Color fundus image; 1932 x 1916 pixels
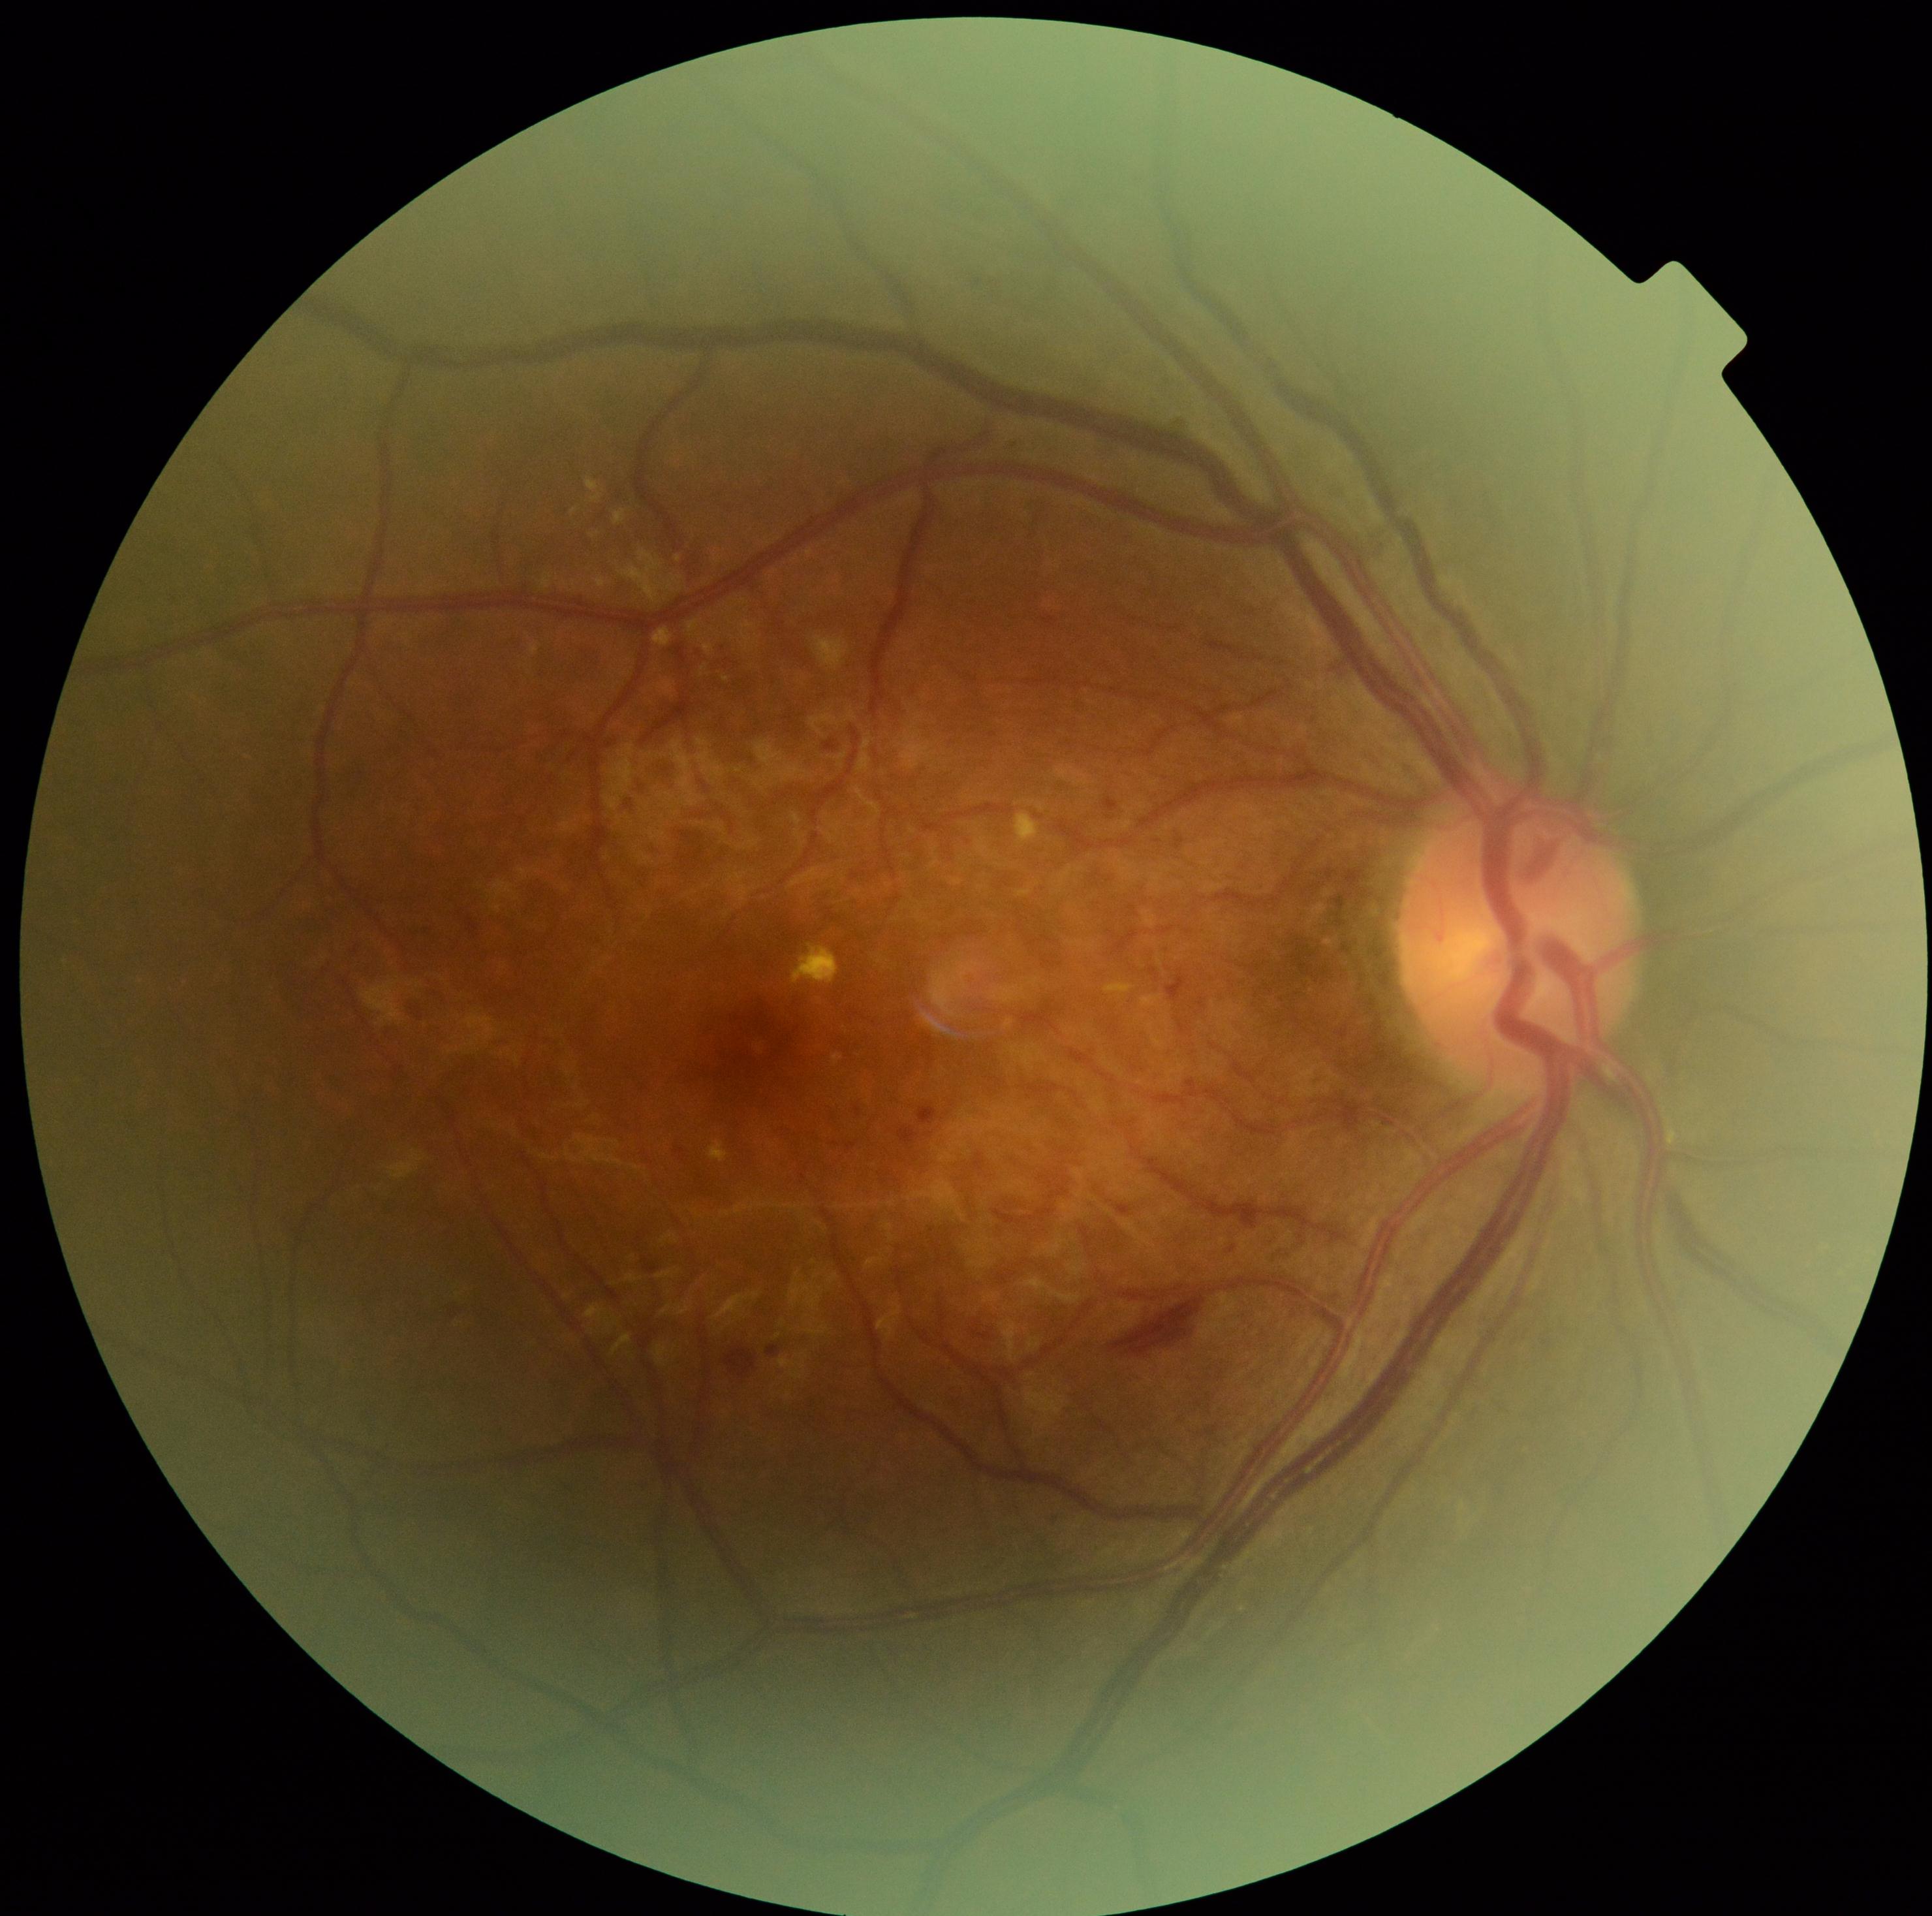 {"dr_grade": "3"}